Pediatric wide-field fundus photograph — 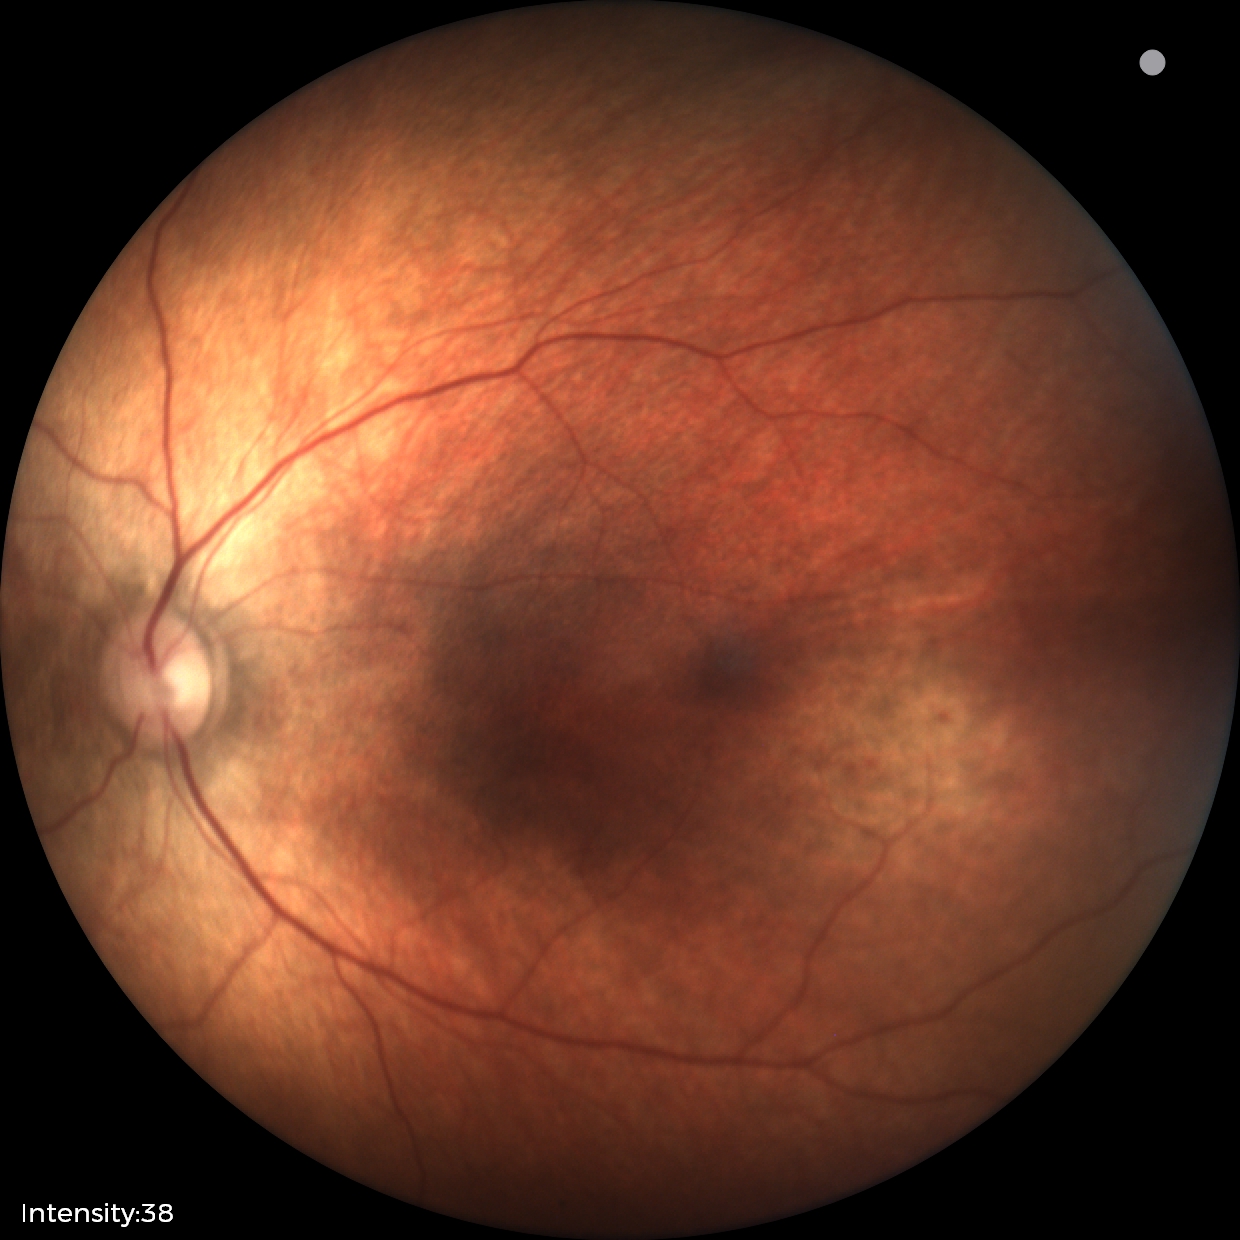
Normal screening examination.